1440 by 1080 pixels · RetCam wide-field infant fundus image — 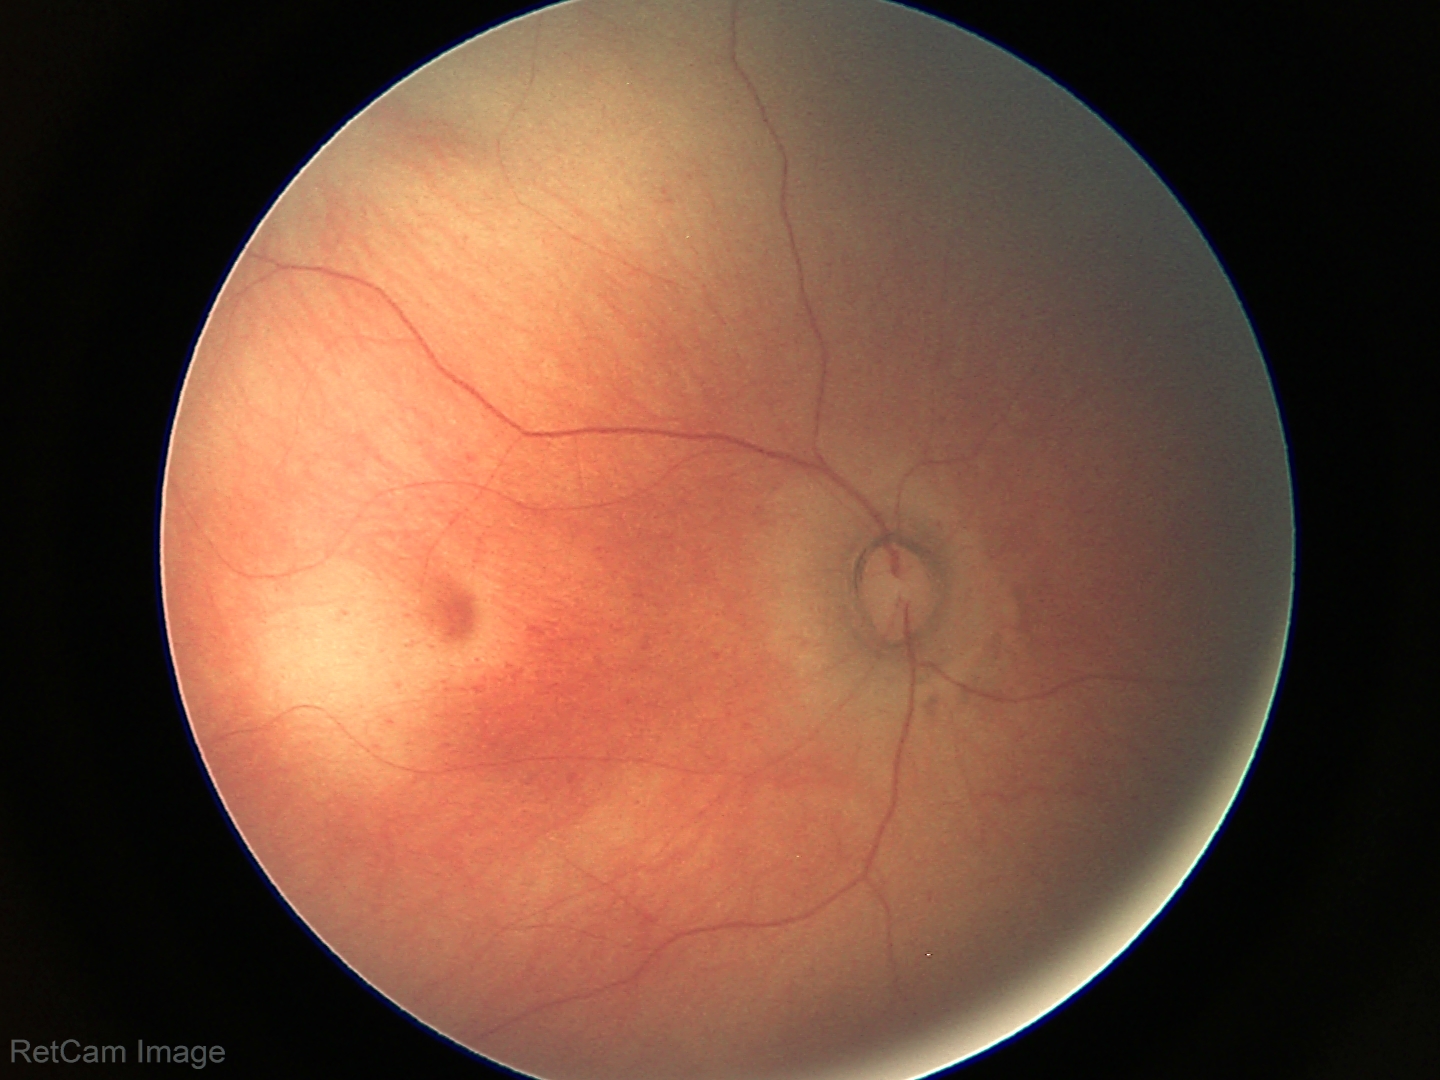 Normal screening examination.